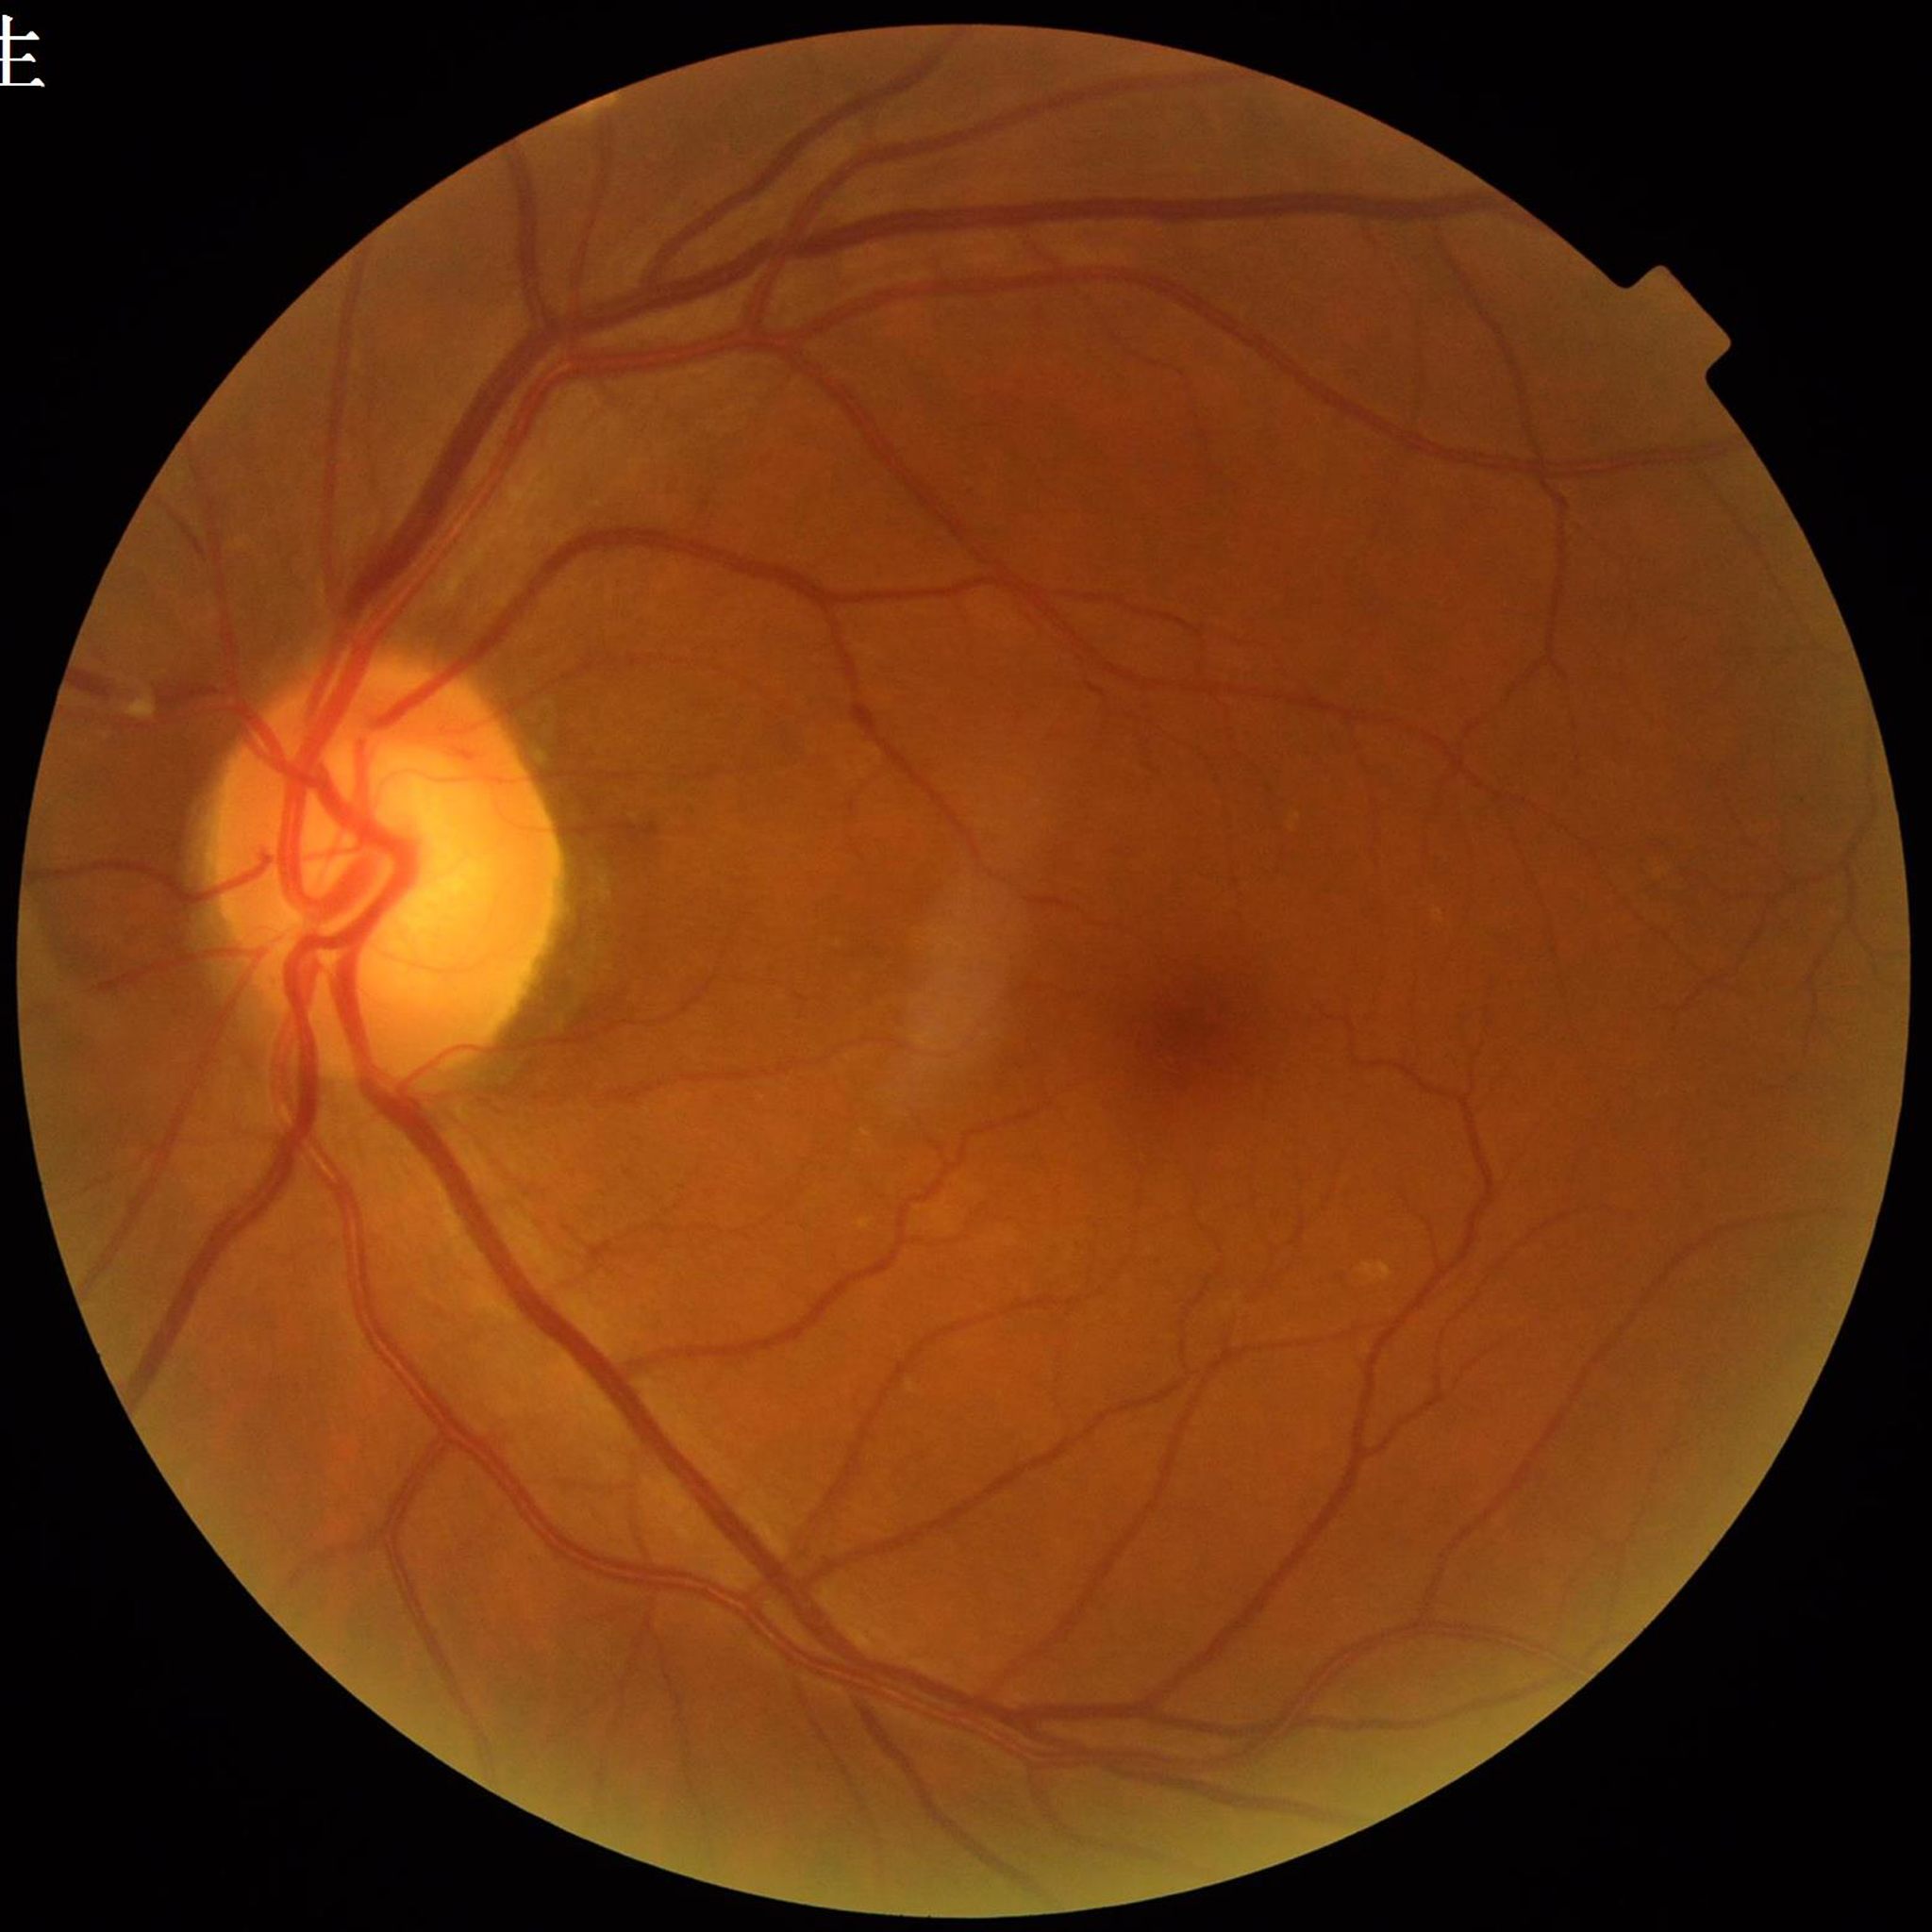

Quality: no quality issues identified | Clinical diagnosis: DR.